RetCam wide-field infant fundus image:
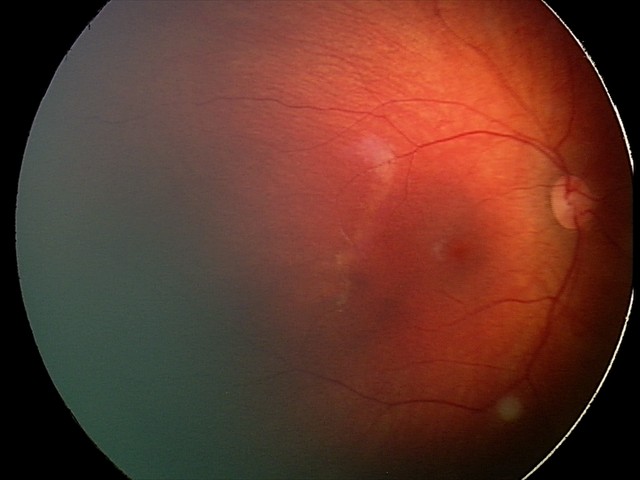
Diagnosis from this screening exam: retinal hemorrhages.